Captured without pupil dilation. Optic disc-centered crop.
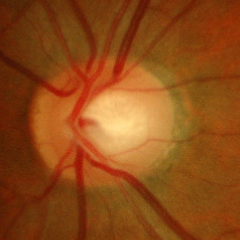 Q: What stage of glaucoma is present?
A: Yes — early glaucoma.